848x848px. Posterior pole photograph. Modified Davis grading
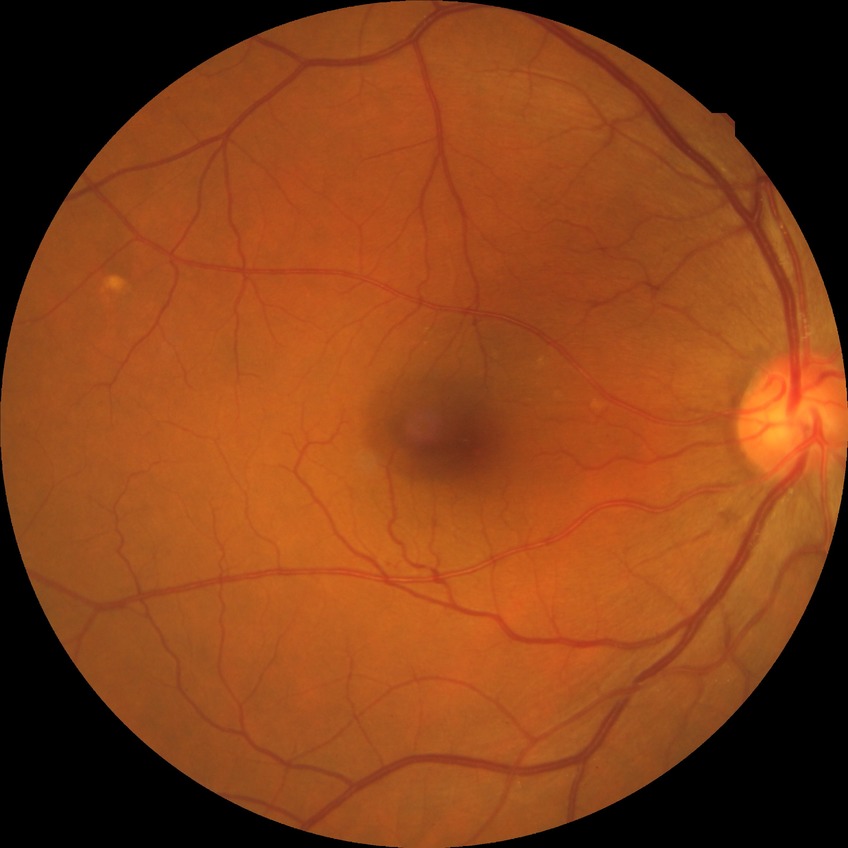
{
  "davis_grade": "no diabetic retinopathy"
}